Captured with the Clarity RetCam 3 (130° field of view) · RetCam wide-field infant fundus image: 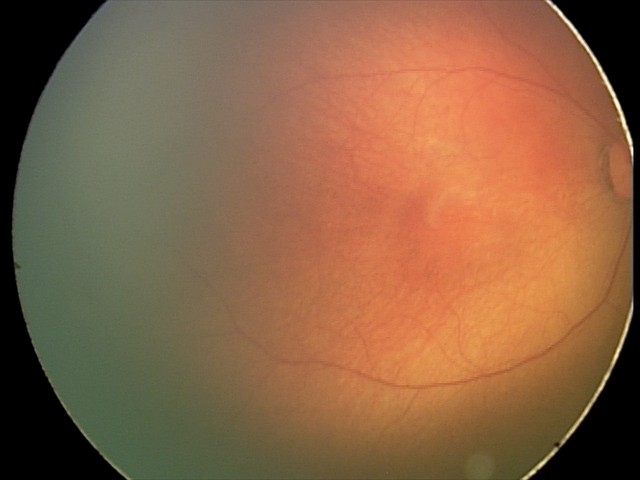 Physiological retinal appearance for postconceptual age.